45 degree fundus photograph; 848x848px; diabetic retinopathy graded by the modified Davis classification
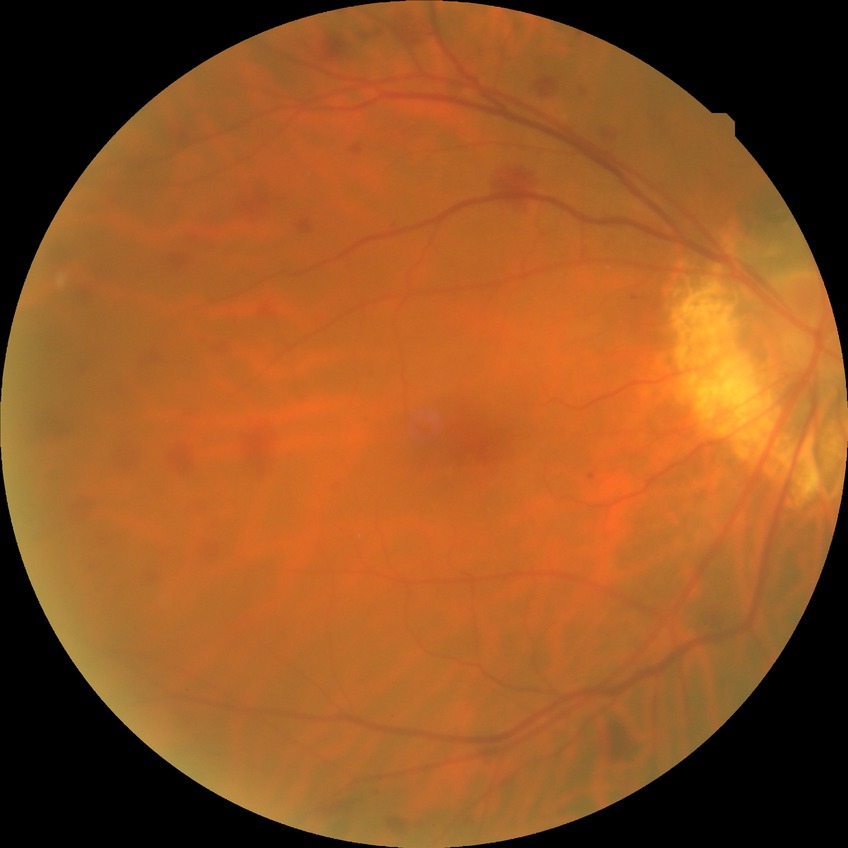
retinopathy stage=simple diabetic retinopathy.